Acquired with a NIDEK AFC-230, nonmydriatic, 45° field of view, posterior pole color fundus photograph.
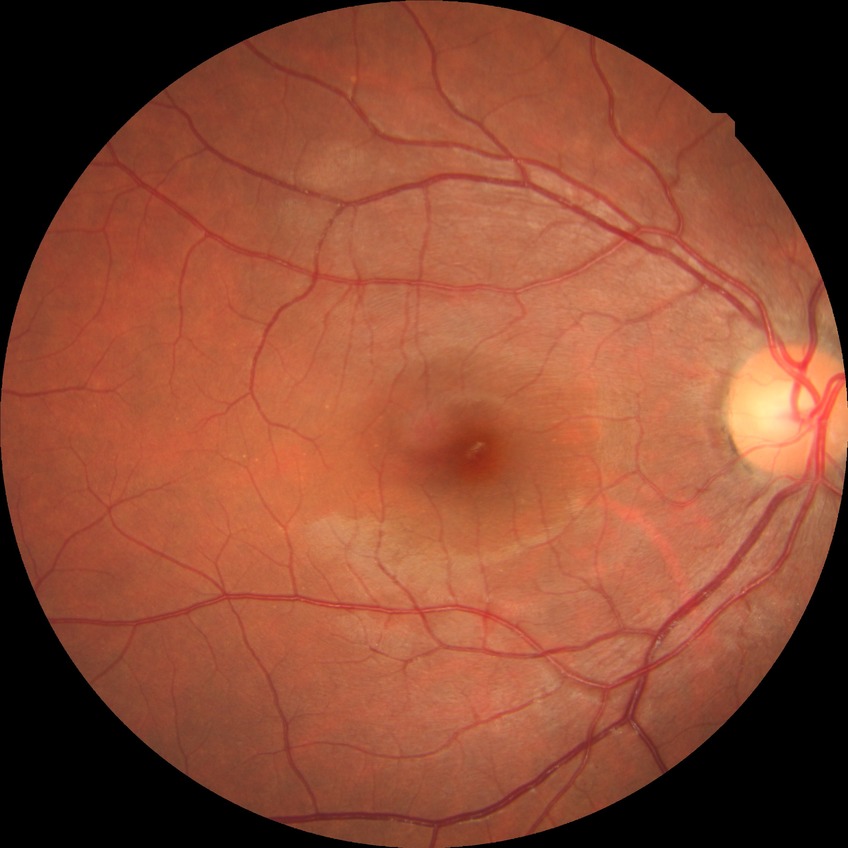 Retinopathy stage is no diabetic retinopathy.